FOV: 45 degrees. 1380x1382px. Color fundus photograph: 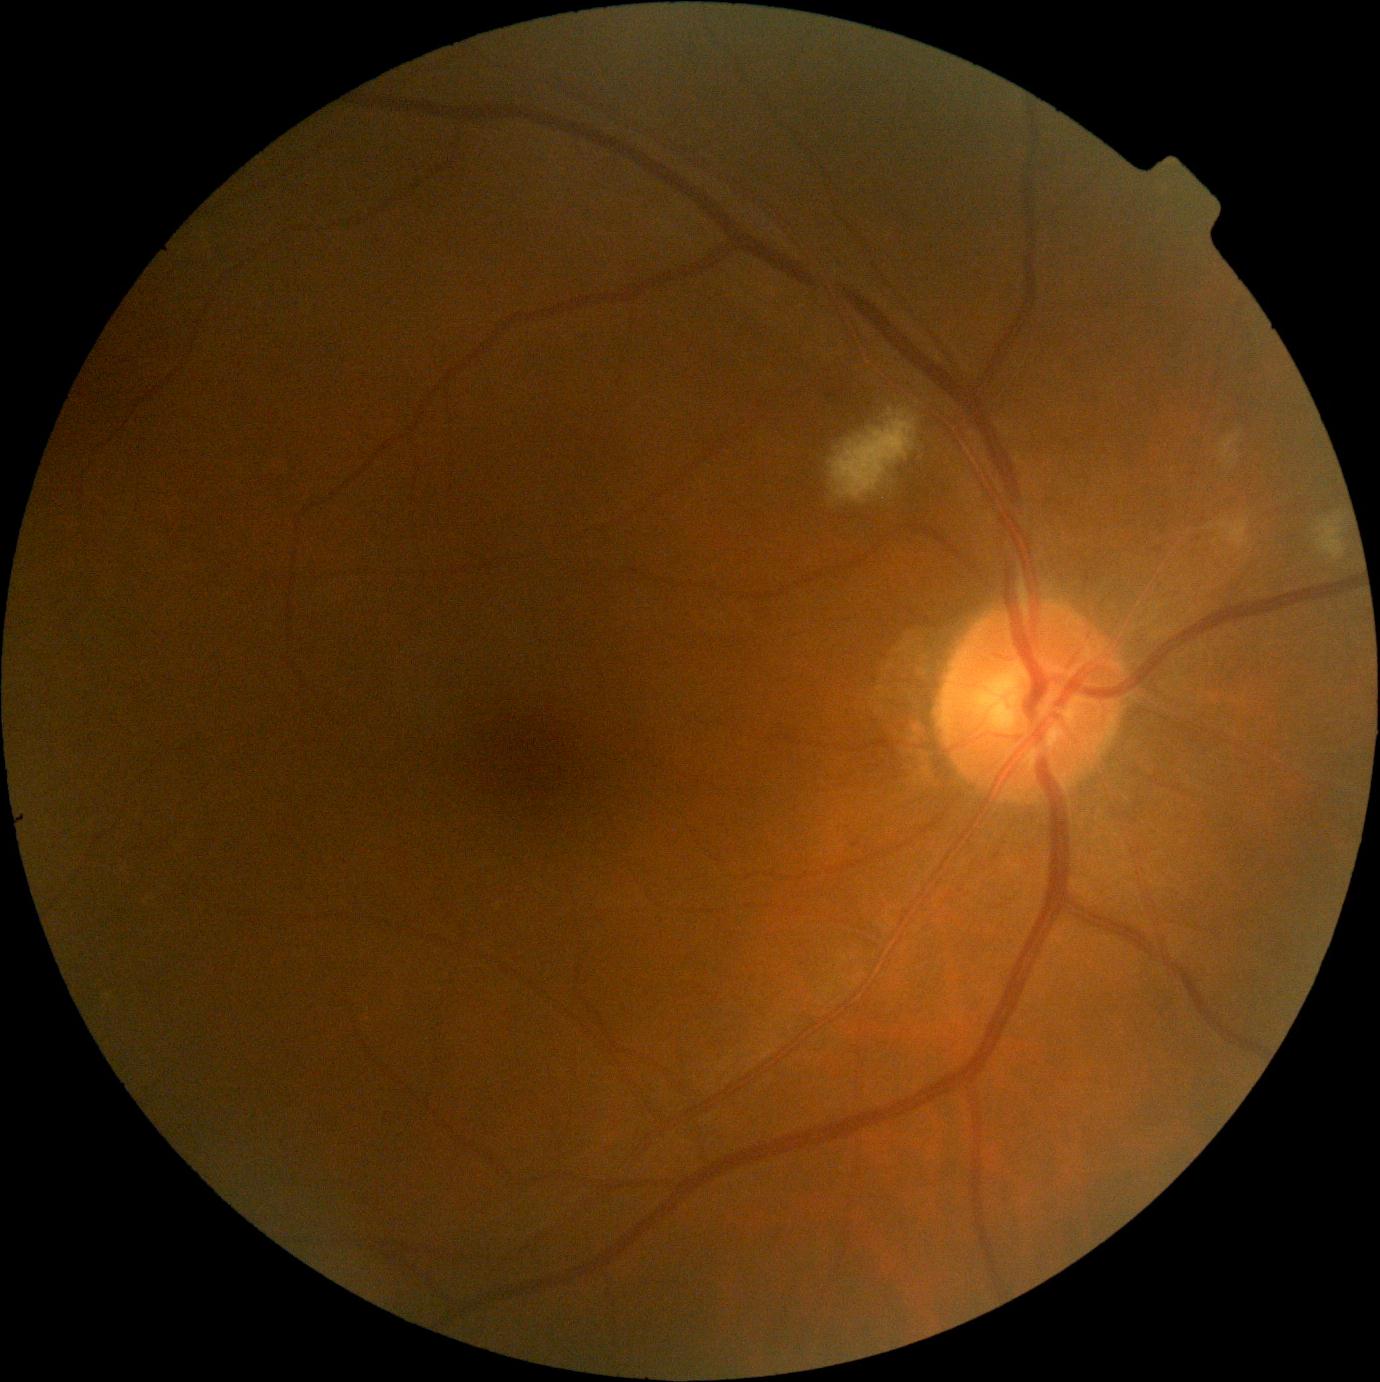
Retinopathy grade: 2/4. DR class: non-proliferative diabetic retinopathy.